Nonmydriatic fundus photograph; NIDEK AFC-230 fundus camera; 848 x 848 pixels
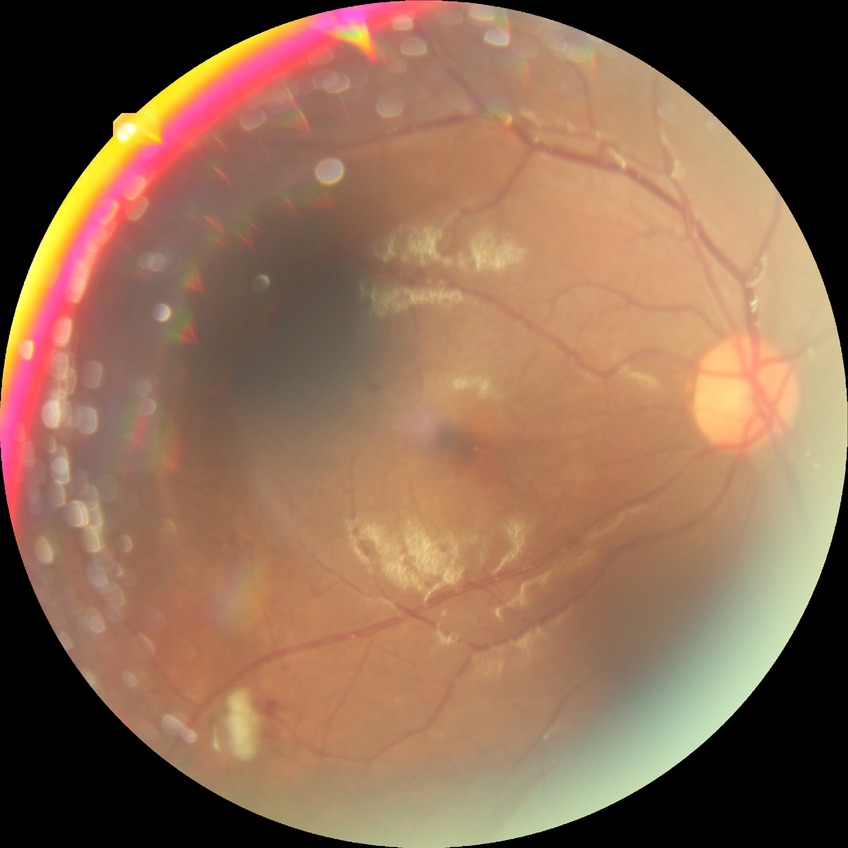

proliferative_class: non-proliferative diabetic retinopathy
davis_grade: pre-proliferative diabetic retinopathy (PPDR)